2352 x 1568 pixels. Fundus photo. FOV: 45 degrees: 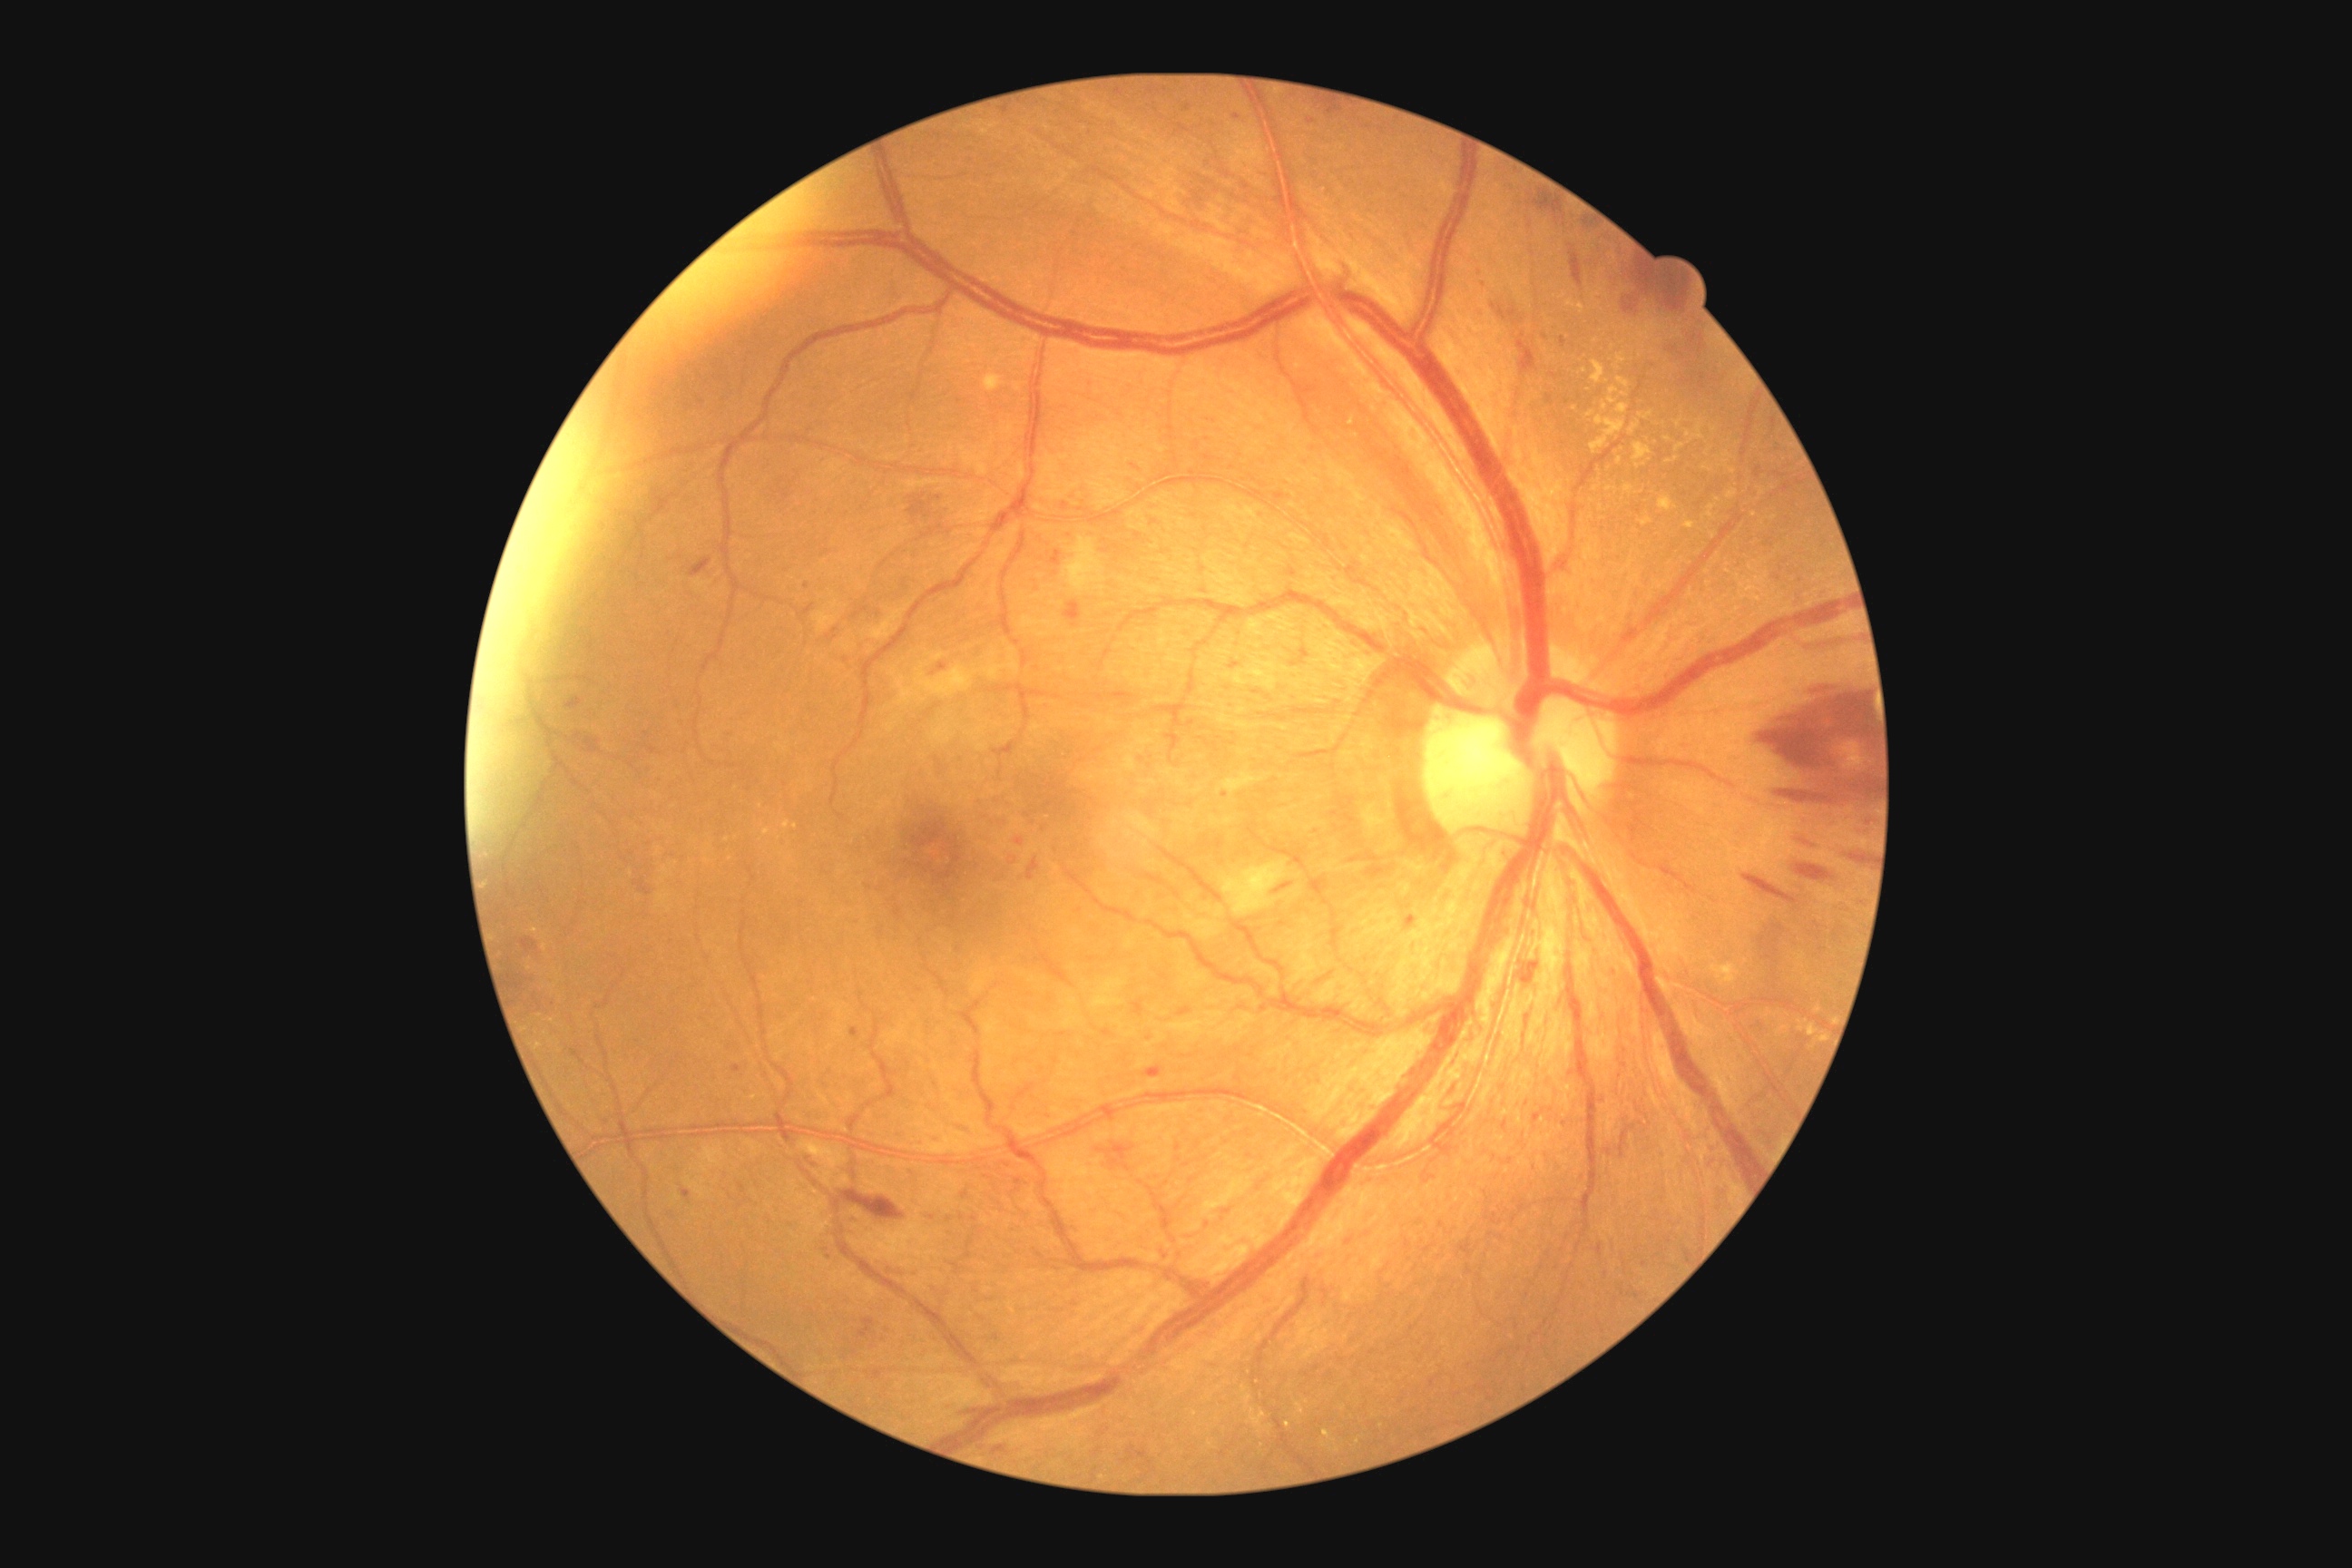

- diabetic retinopathy grade — 2/4